1240 by 1240 pixels. 100° field of view (Phoenix ICON). Wide-field fundus photograph from neonatal ROP screening:
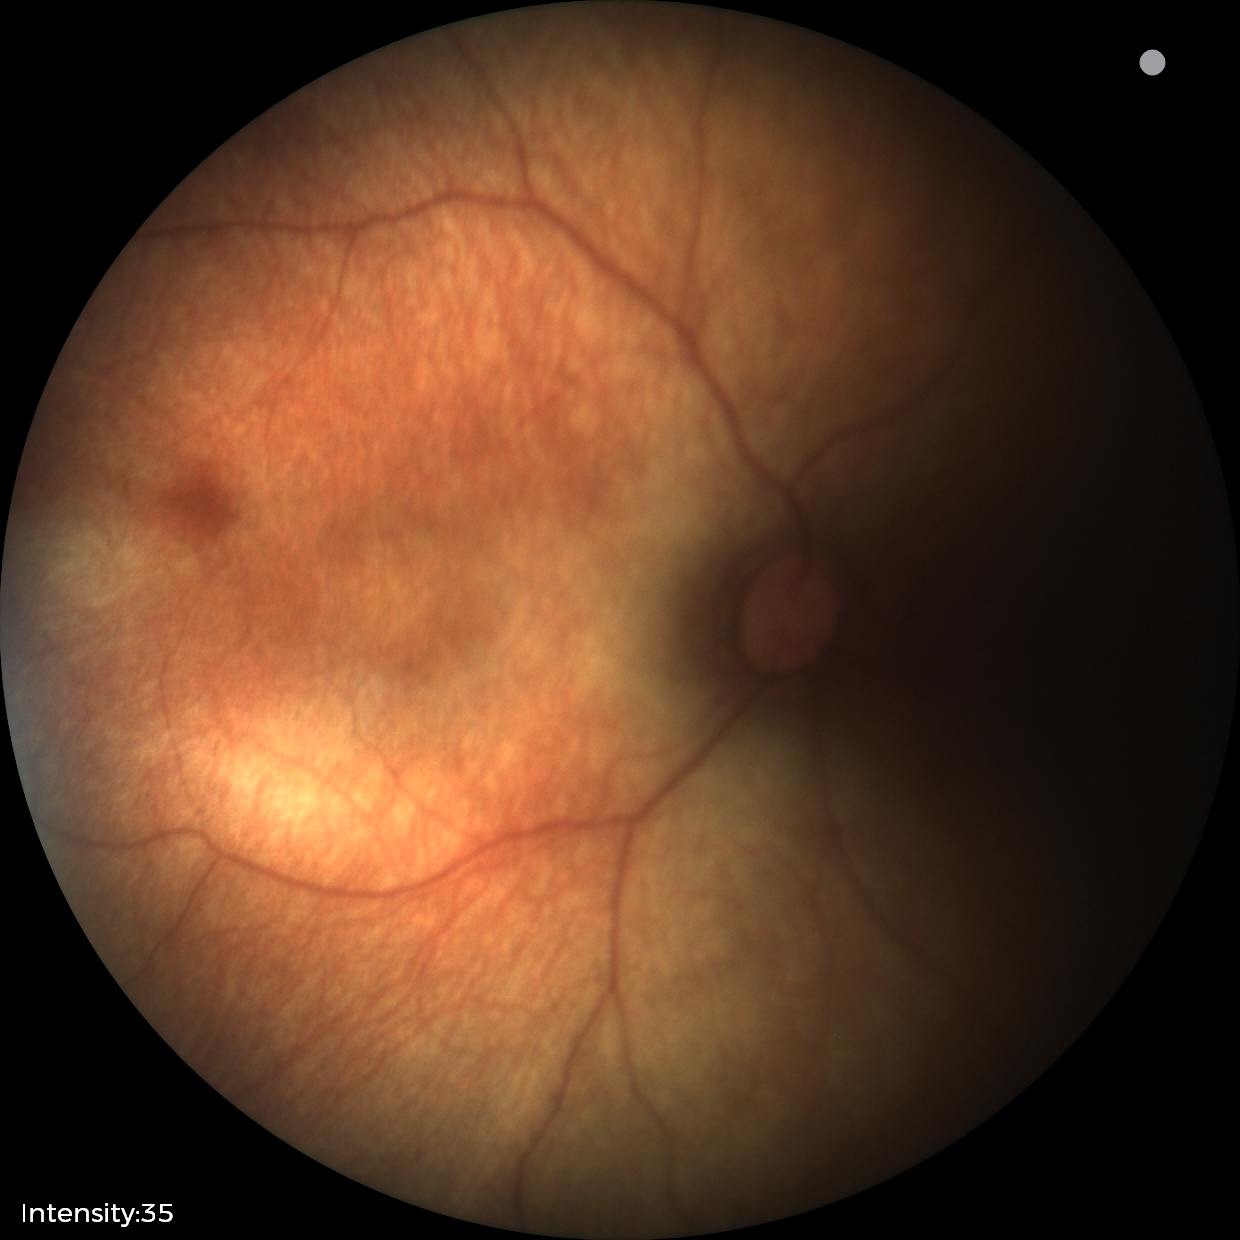 Screening diagnosis: no abnormal retinal findings.